45° FOV; 2048 by 1536 pixels; color fundus image:
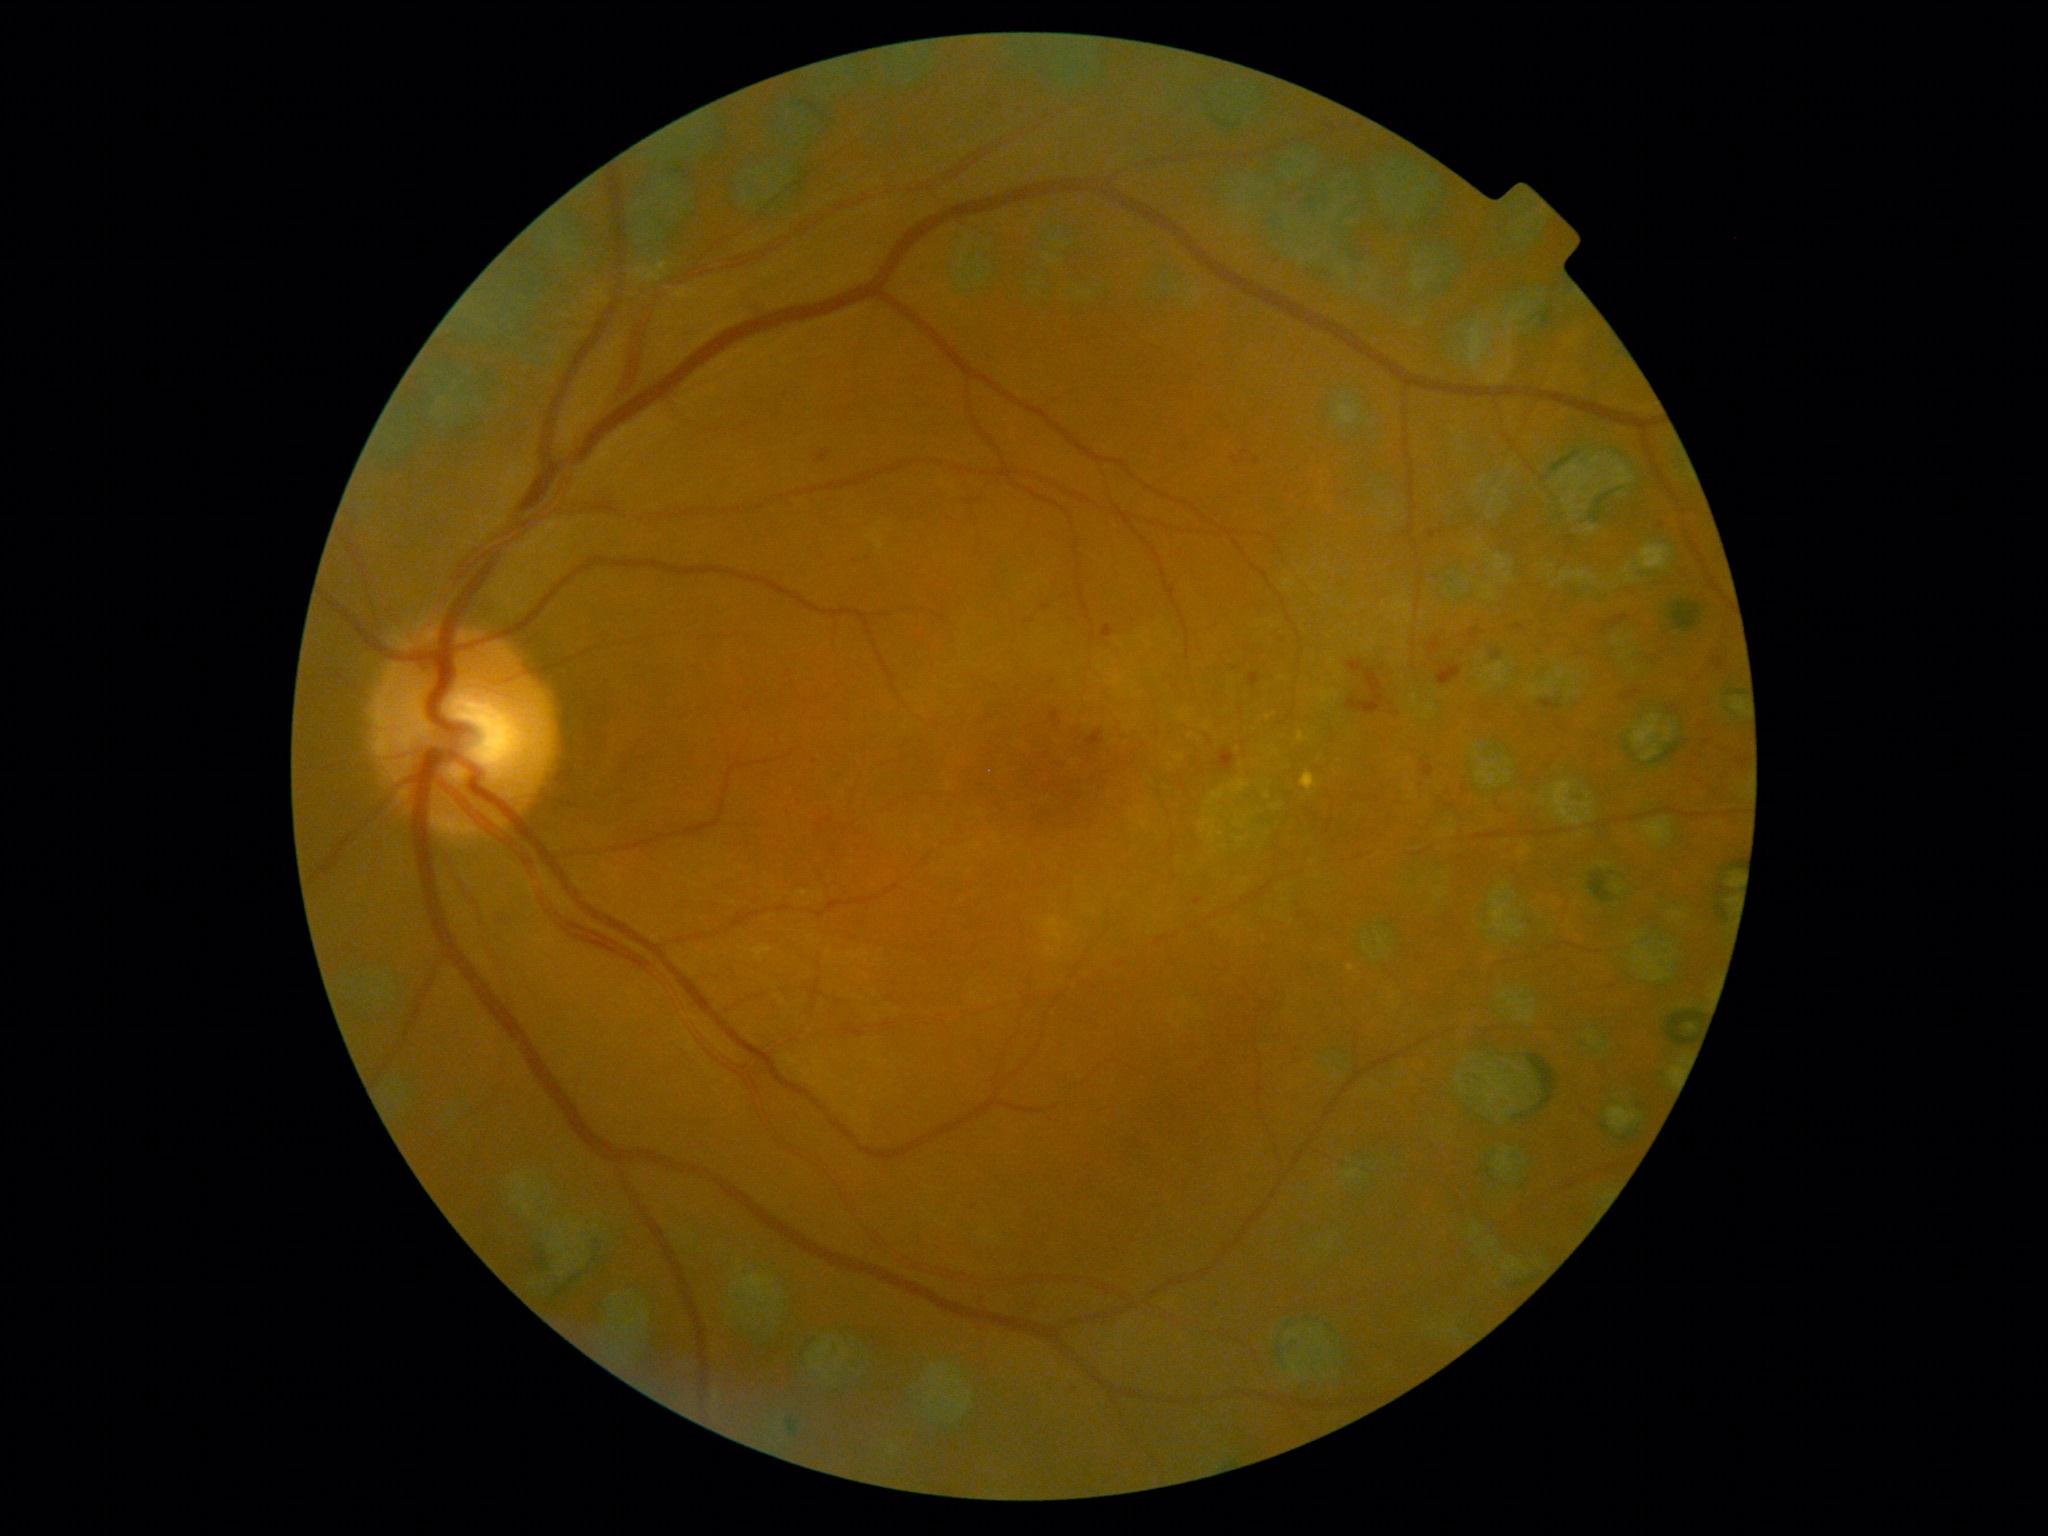

<lesions partial="true">
  <dr_grade>2</dr_grade>
  <he>bbox=(1041, 605, 1051, 611), bbox=(1218, 749, 1236, 772), bbox=(1347, 660, 1384, 714), bbox=(1051, 710, 1060, 723), bbox=(1429, 637, 1441, 656), bbox=(1437, 663, 1462, 686), bbox=(819, 452, 832, 462), bbox=(1713, 658, 1726, 671), bbox=(1737, 753, 1750, 770), bbox=(1421, 760, 1434, 778), bbox=(1026, 618, 1034, 624), bbox=(1691, 740, 1713, 747), bbox=(1249, 674, 1261, 687), bbox=(1621, 687, 1642, 702), bbox=(1696, 720, 1708, 726), bbox=(1470, 628, 1480, 640), bbox=(1086, 730, 1104, 747), bbox=(1602, 615, 1629, 633)</he>
  <ma partial="true">bbox=(1429, 531, 1436, 539), bbox=(1102, 625, 1114, 638), bbox=(1193, 898, 1203, 907)</ma>
  <ma_small_approx>{"x": 1257, "y": 462}, {"x": 1238, "y": 463}, {"x": 1662, "y": 526}, {"x": 1072, "y": 1387}, {"x": 973, "y": 1209}, {"x": 869, "y": 559}, {"x": 1053, "y": 682}</ma_small_approx>
  <ex>bbox=(1301, 772, 1318, 795)</ex>
  <ex_small_approx>{"x": 1351, "y": 968}</ex_small_approx>
  <se />
</lesions>